848x848; nonmydriatic fundus photograph; 45-degree field of view
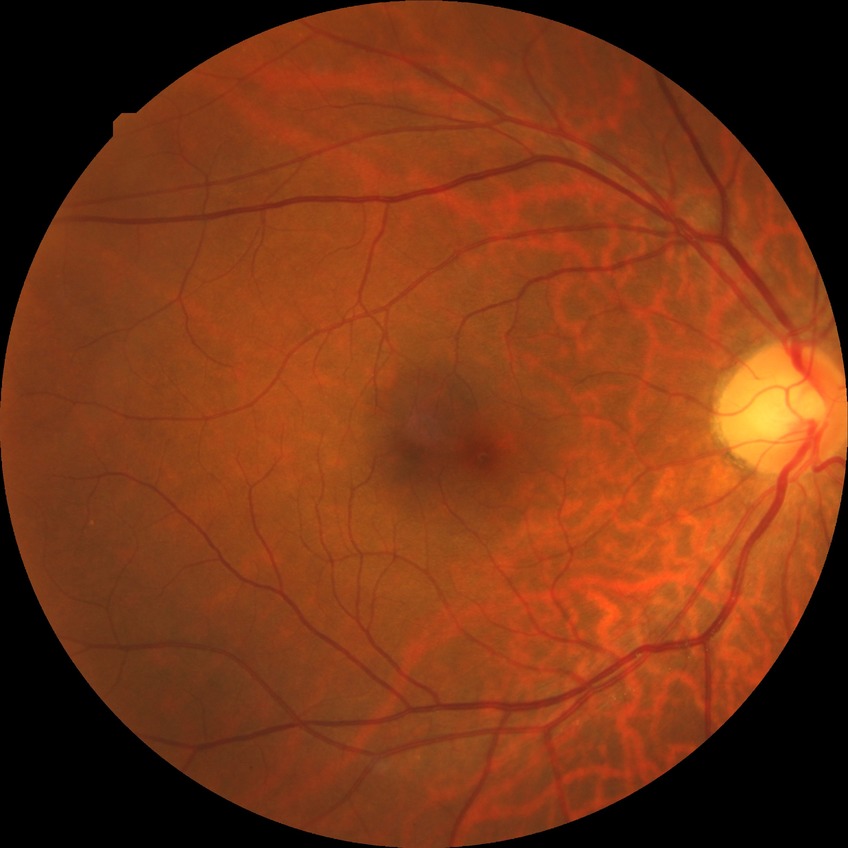
Retinopathy grade: no diabetic retinopathy.